2212 by 1659 pixels — 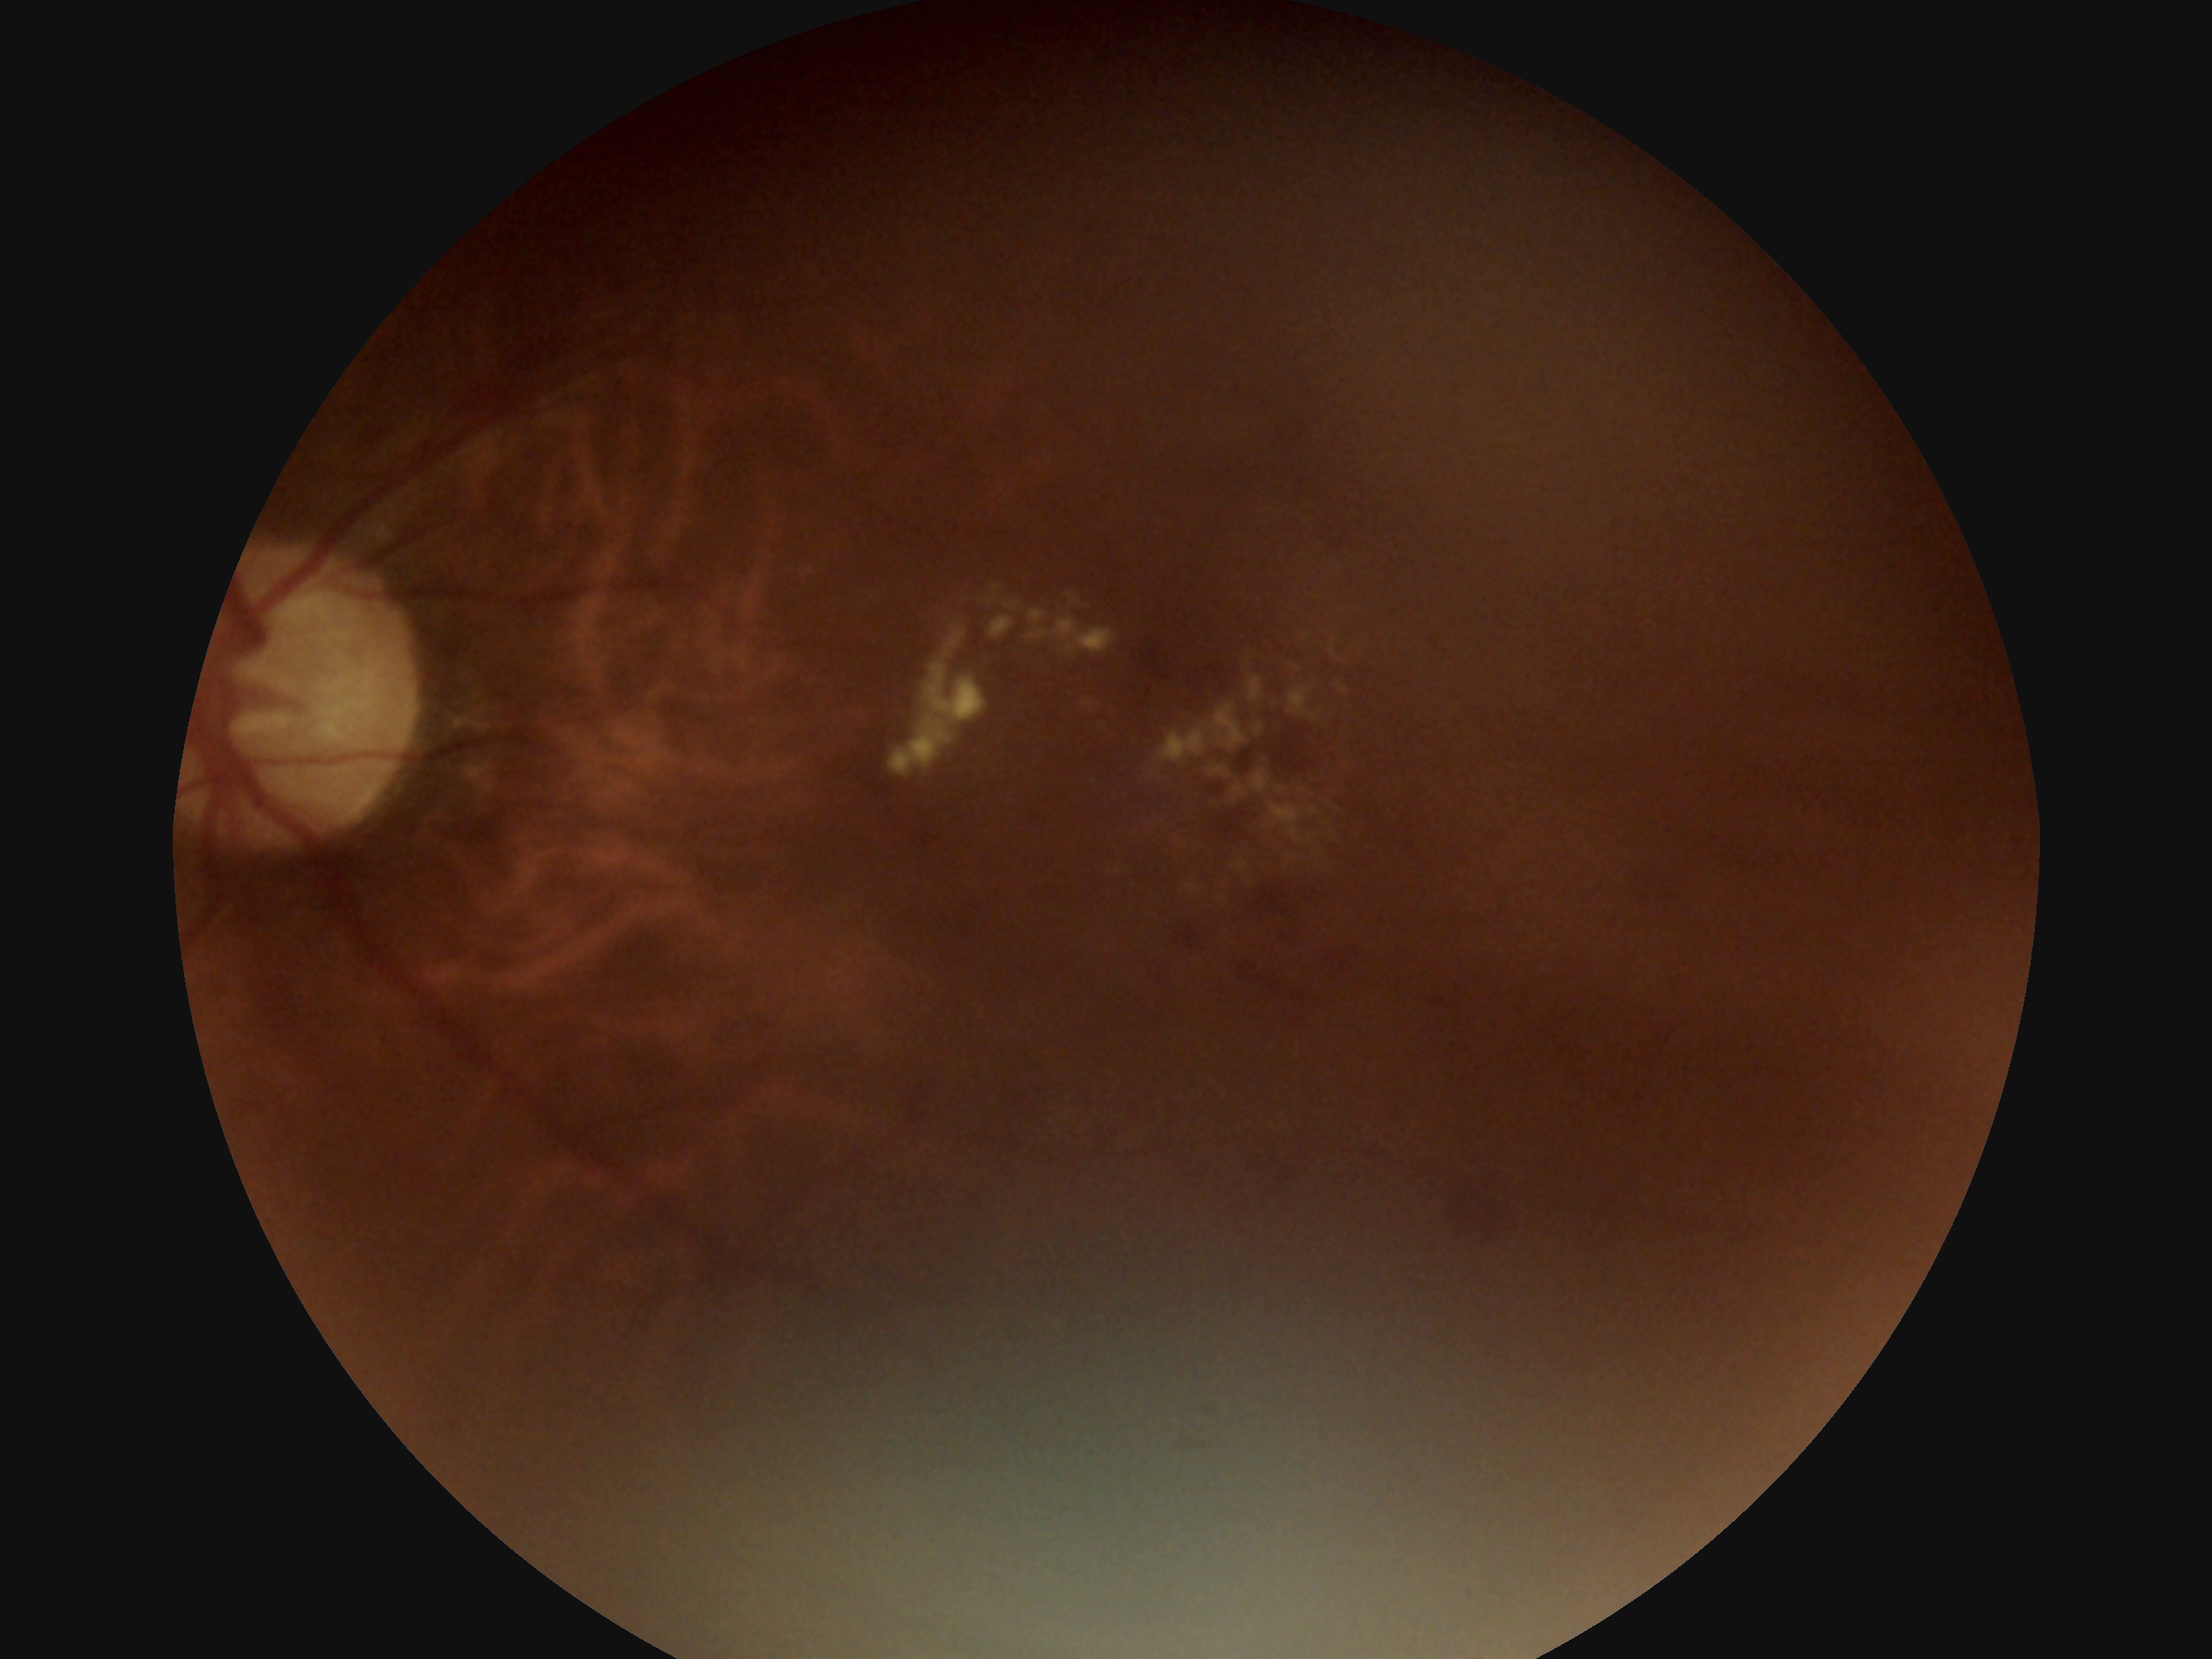
DR grade=2 (moderate NPDR).